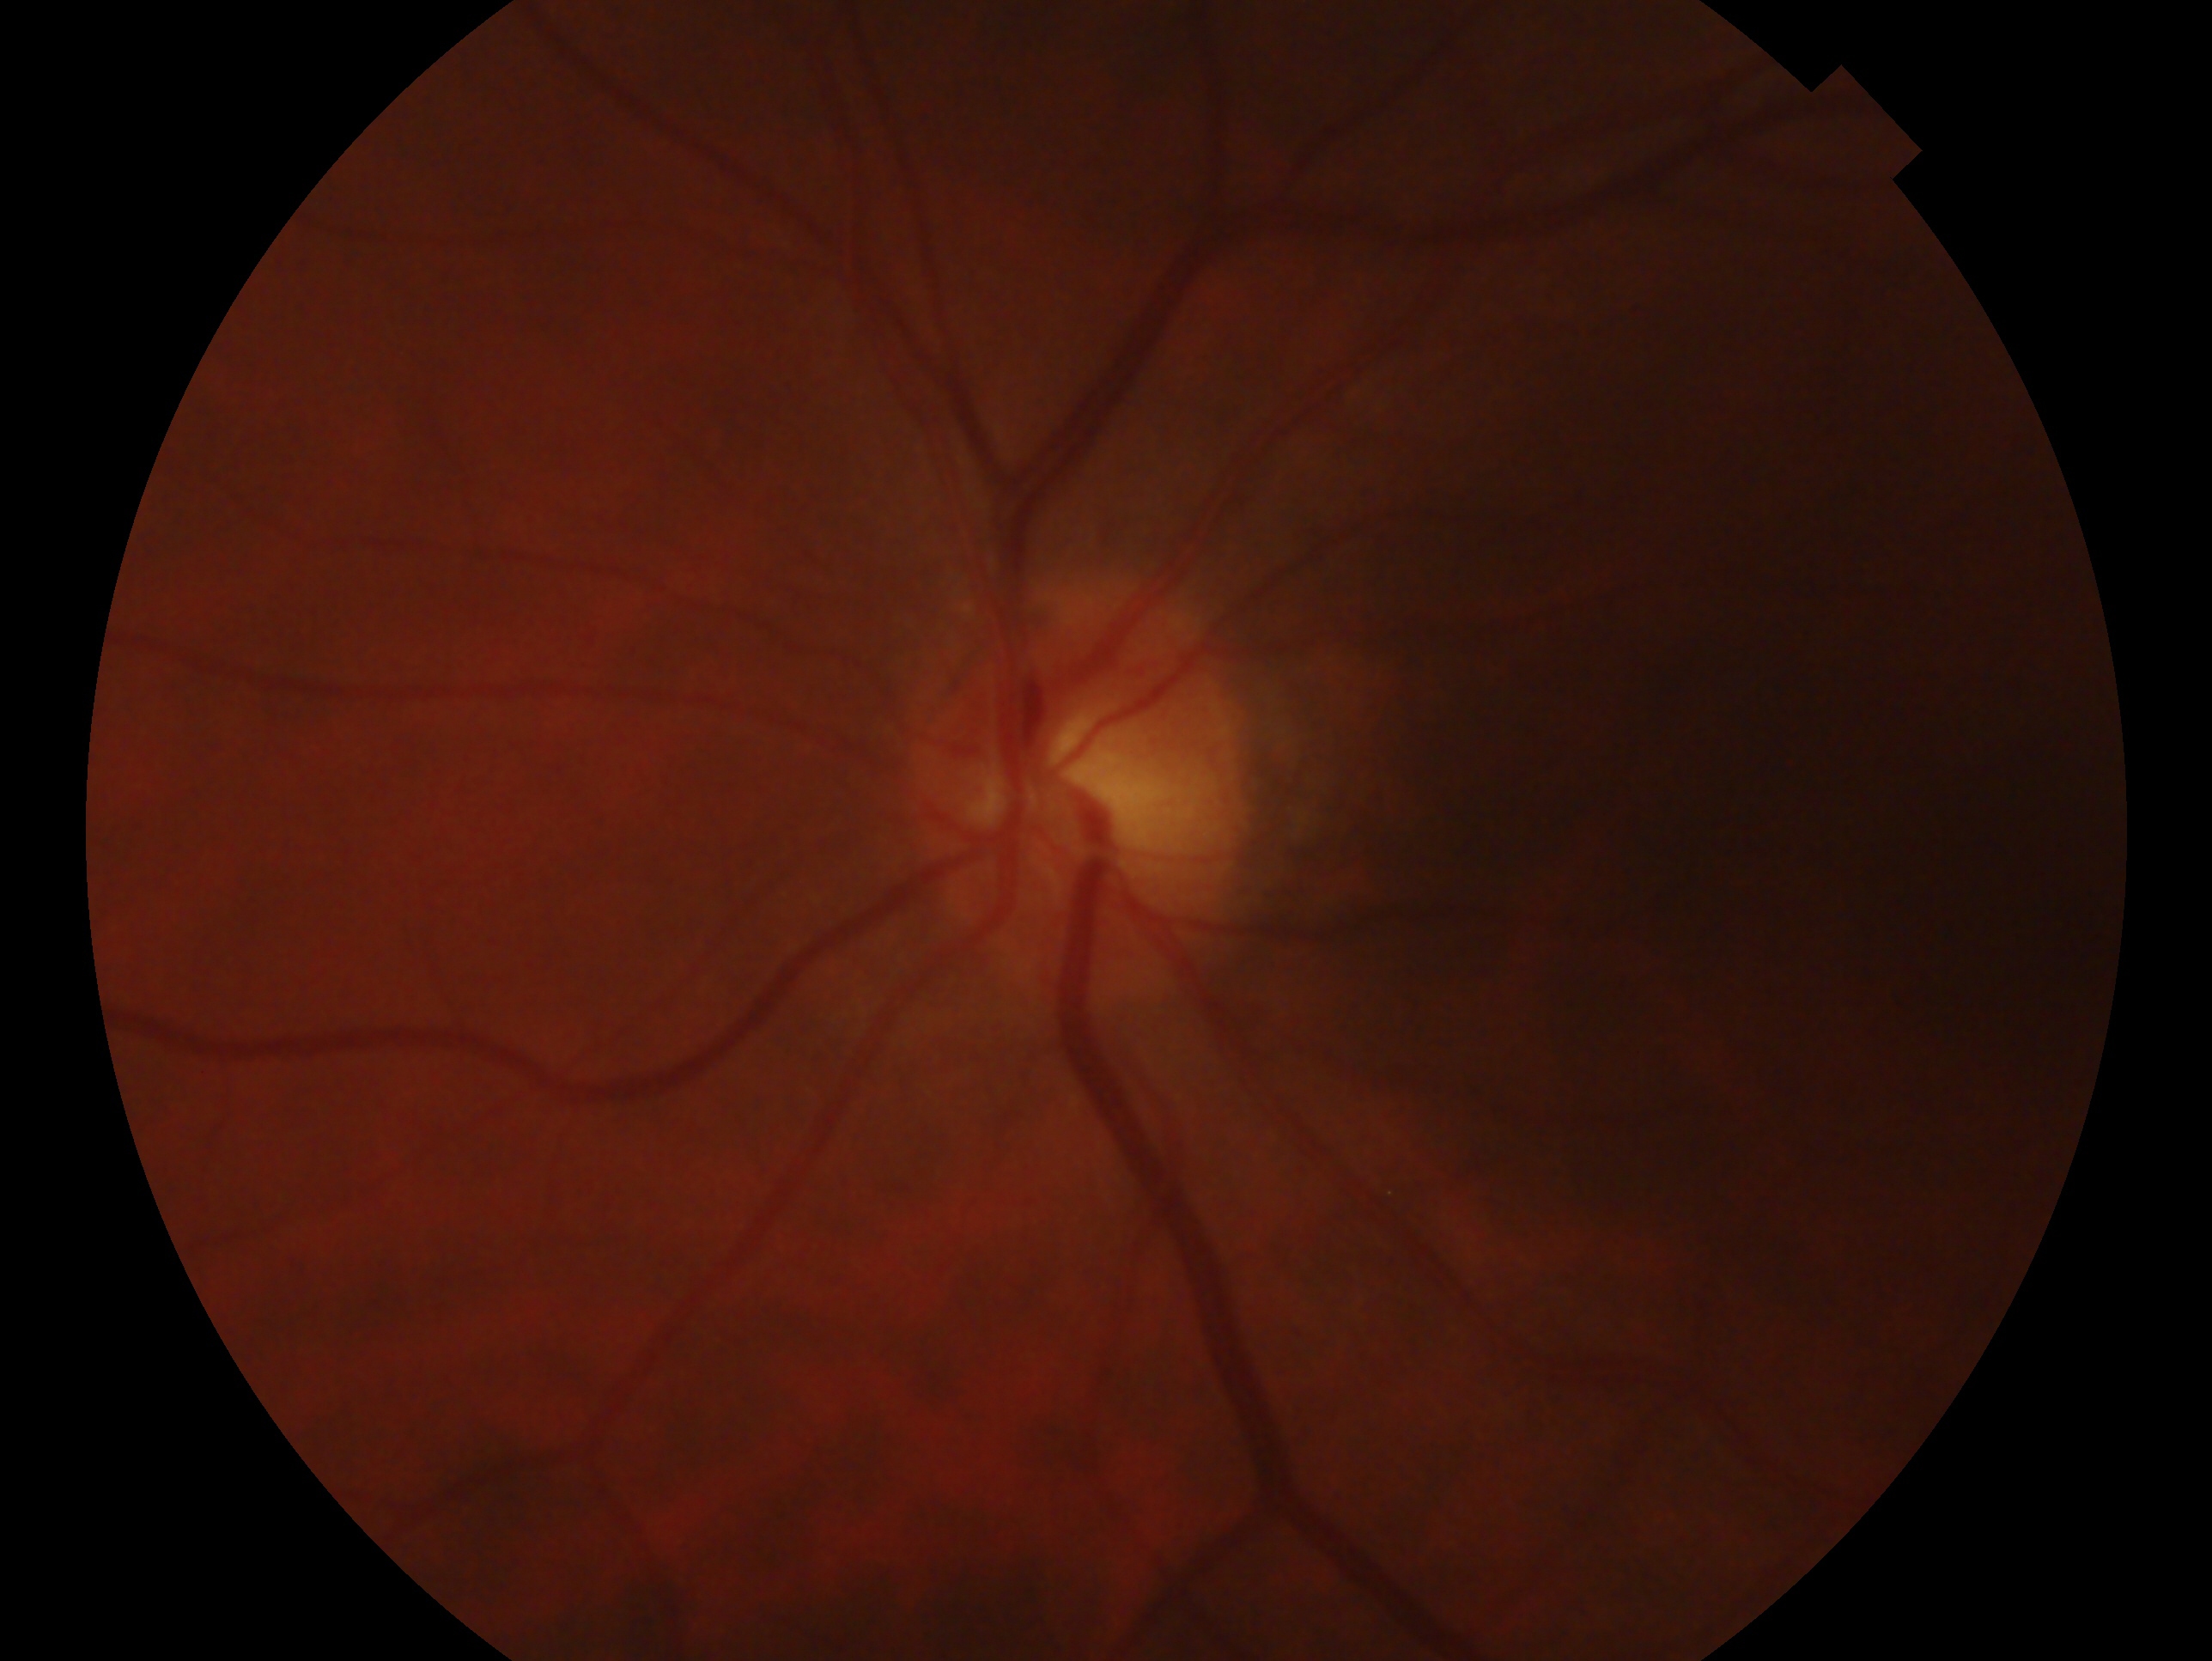
Eye: left eye. Glaucoma status: no evidence of glaucoma.